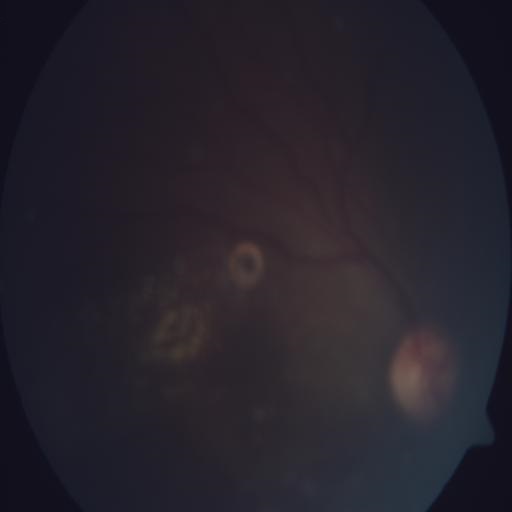
Pathology:
- exudation